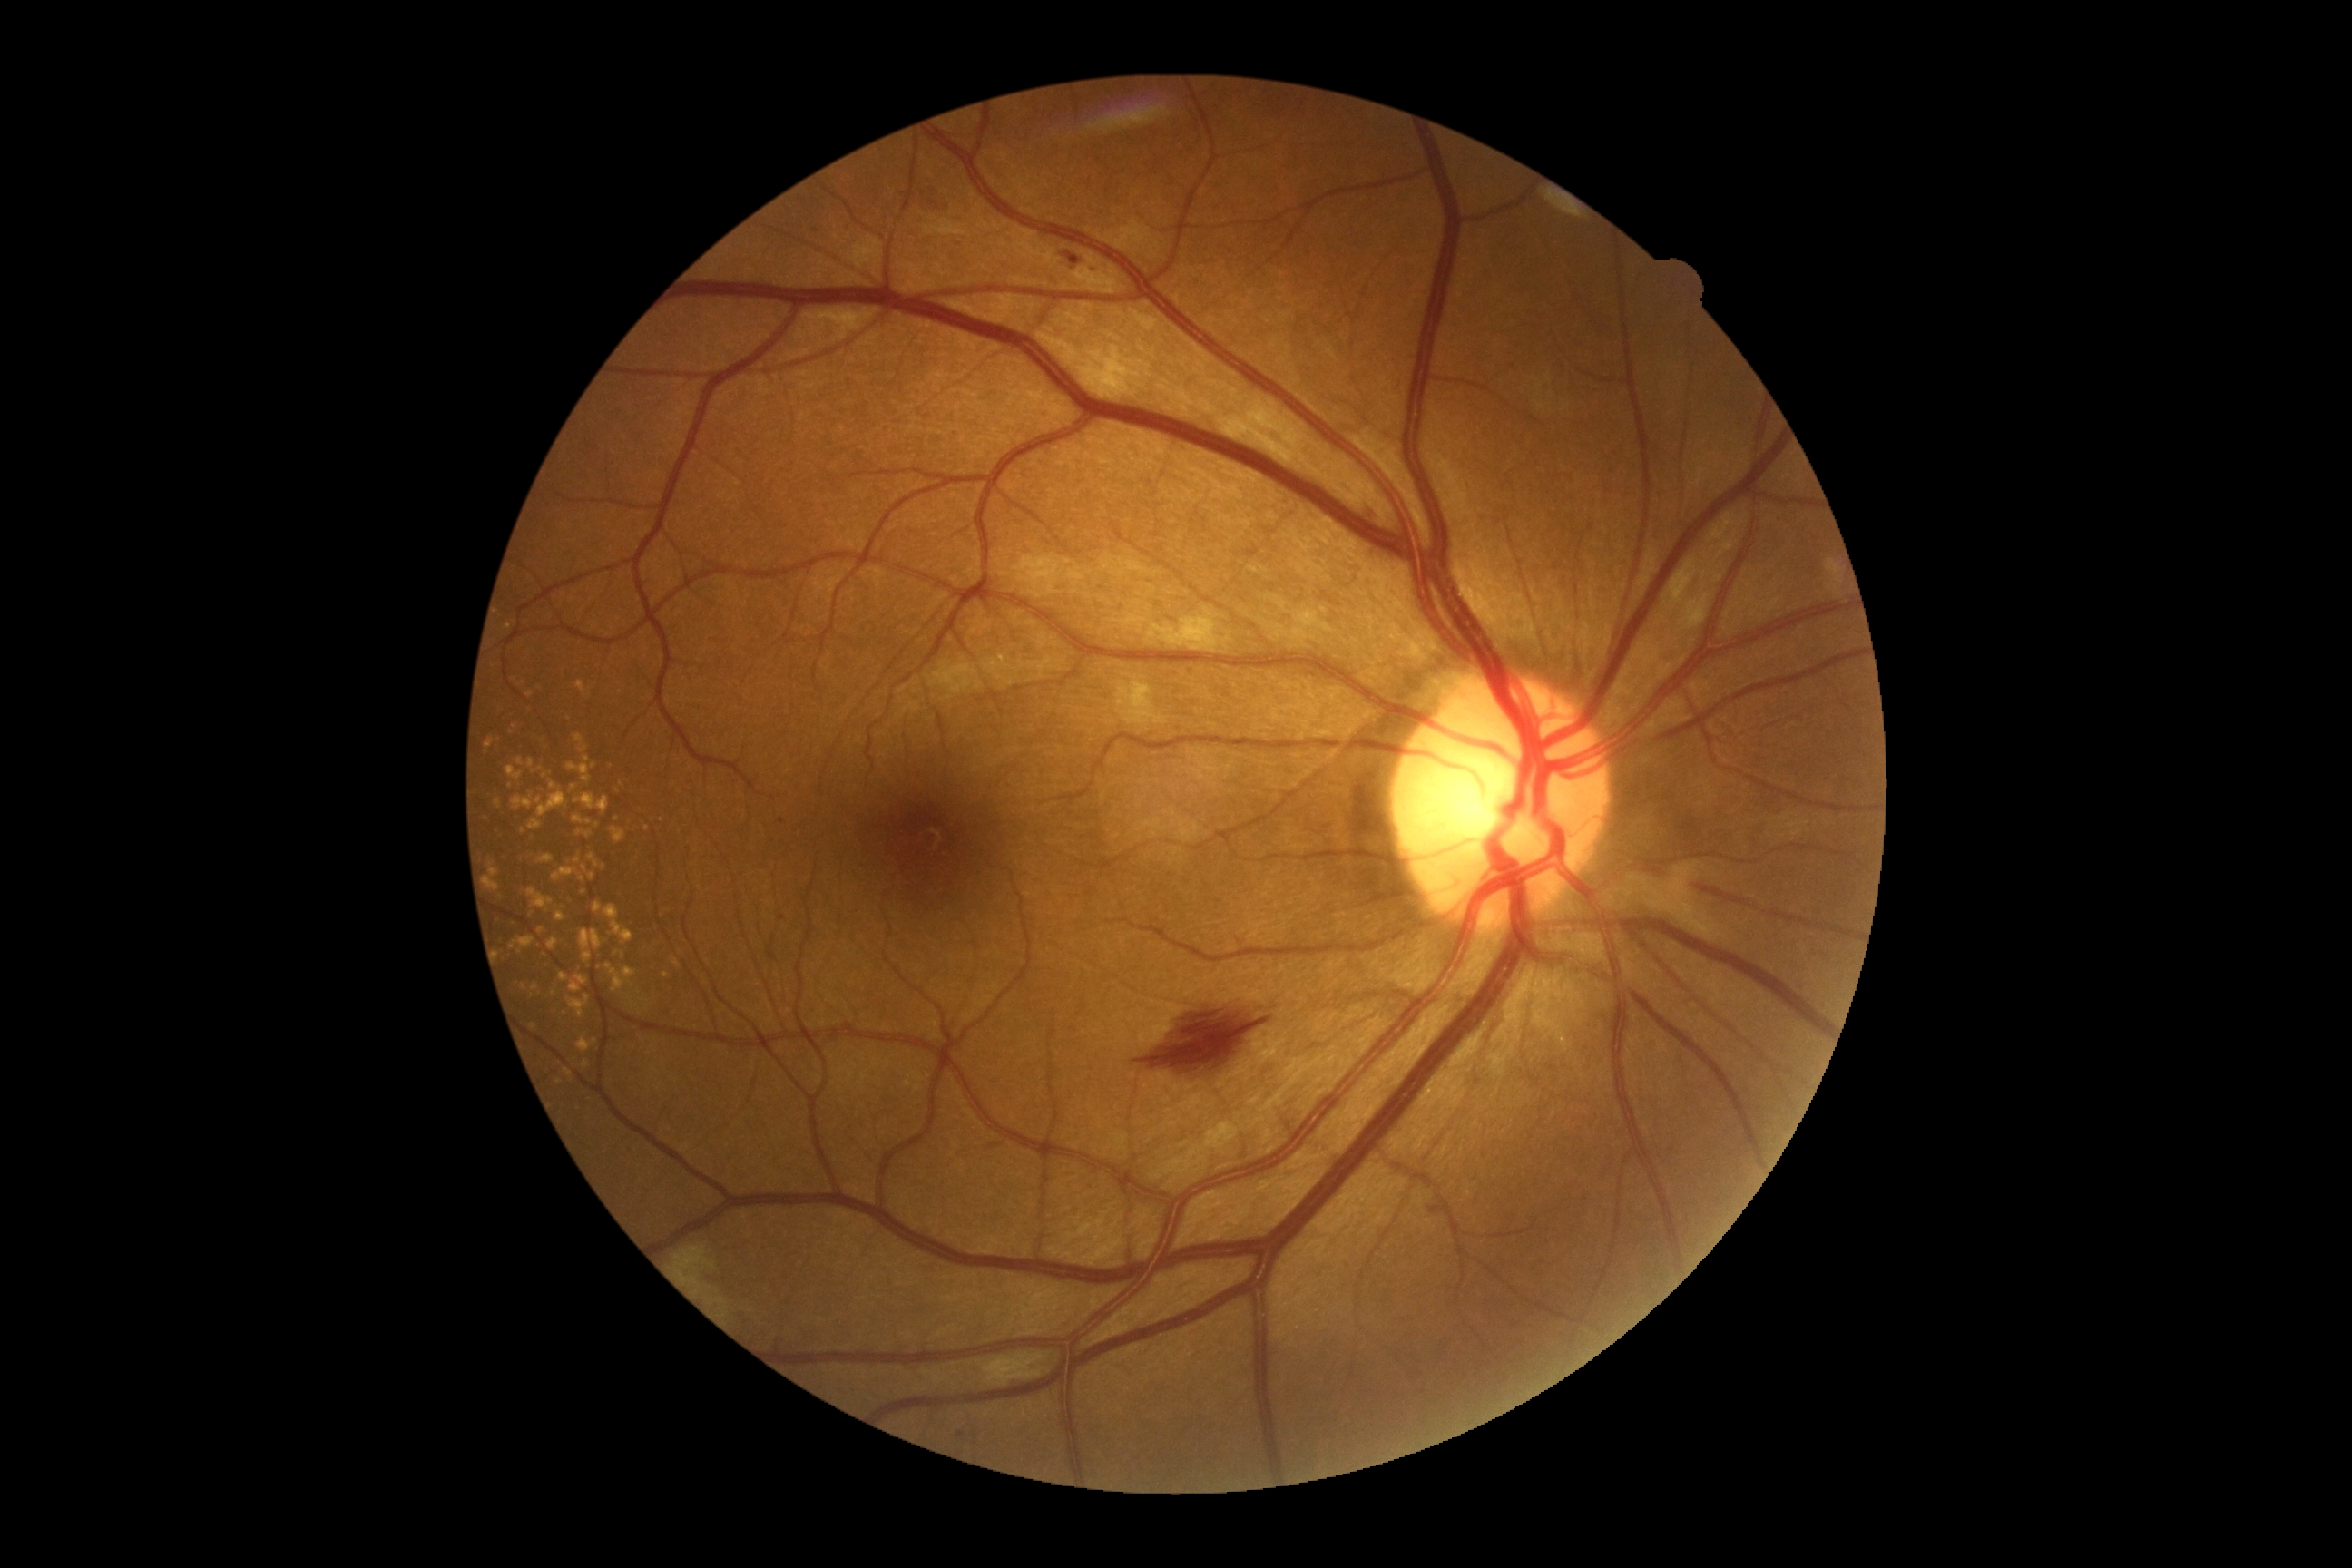
DR grade: 2/4 — more than just microaneurysms but less than severe NPDR
* HEs: 1064 251 1083 270 | 1362 500 1382 522 | 1088 266 1101 277 | 1130 1001 1279 1079
* EXs: none identified
* SEs: 1665 558 1710 632 | 1117 676 1170 727 | 1709 513 1745 564 | 1083 346 1132 400 | 674 1244 732 1318 | 1148 605 1233 654 | 983 1353 1052 1387
* MAs: 1427 1200 1442 1217 | 1190 669 1195 678 | 957 1433 965 1440
* Additional small MAs near [x=782, y=918] | [x=782, y=822]